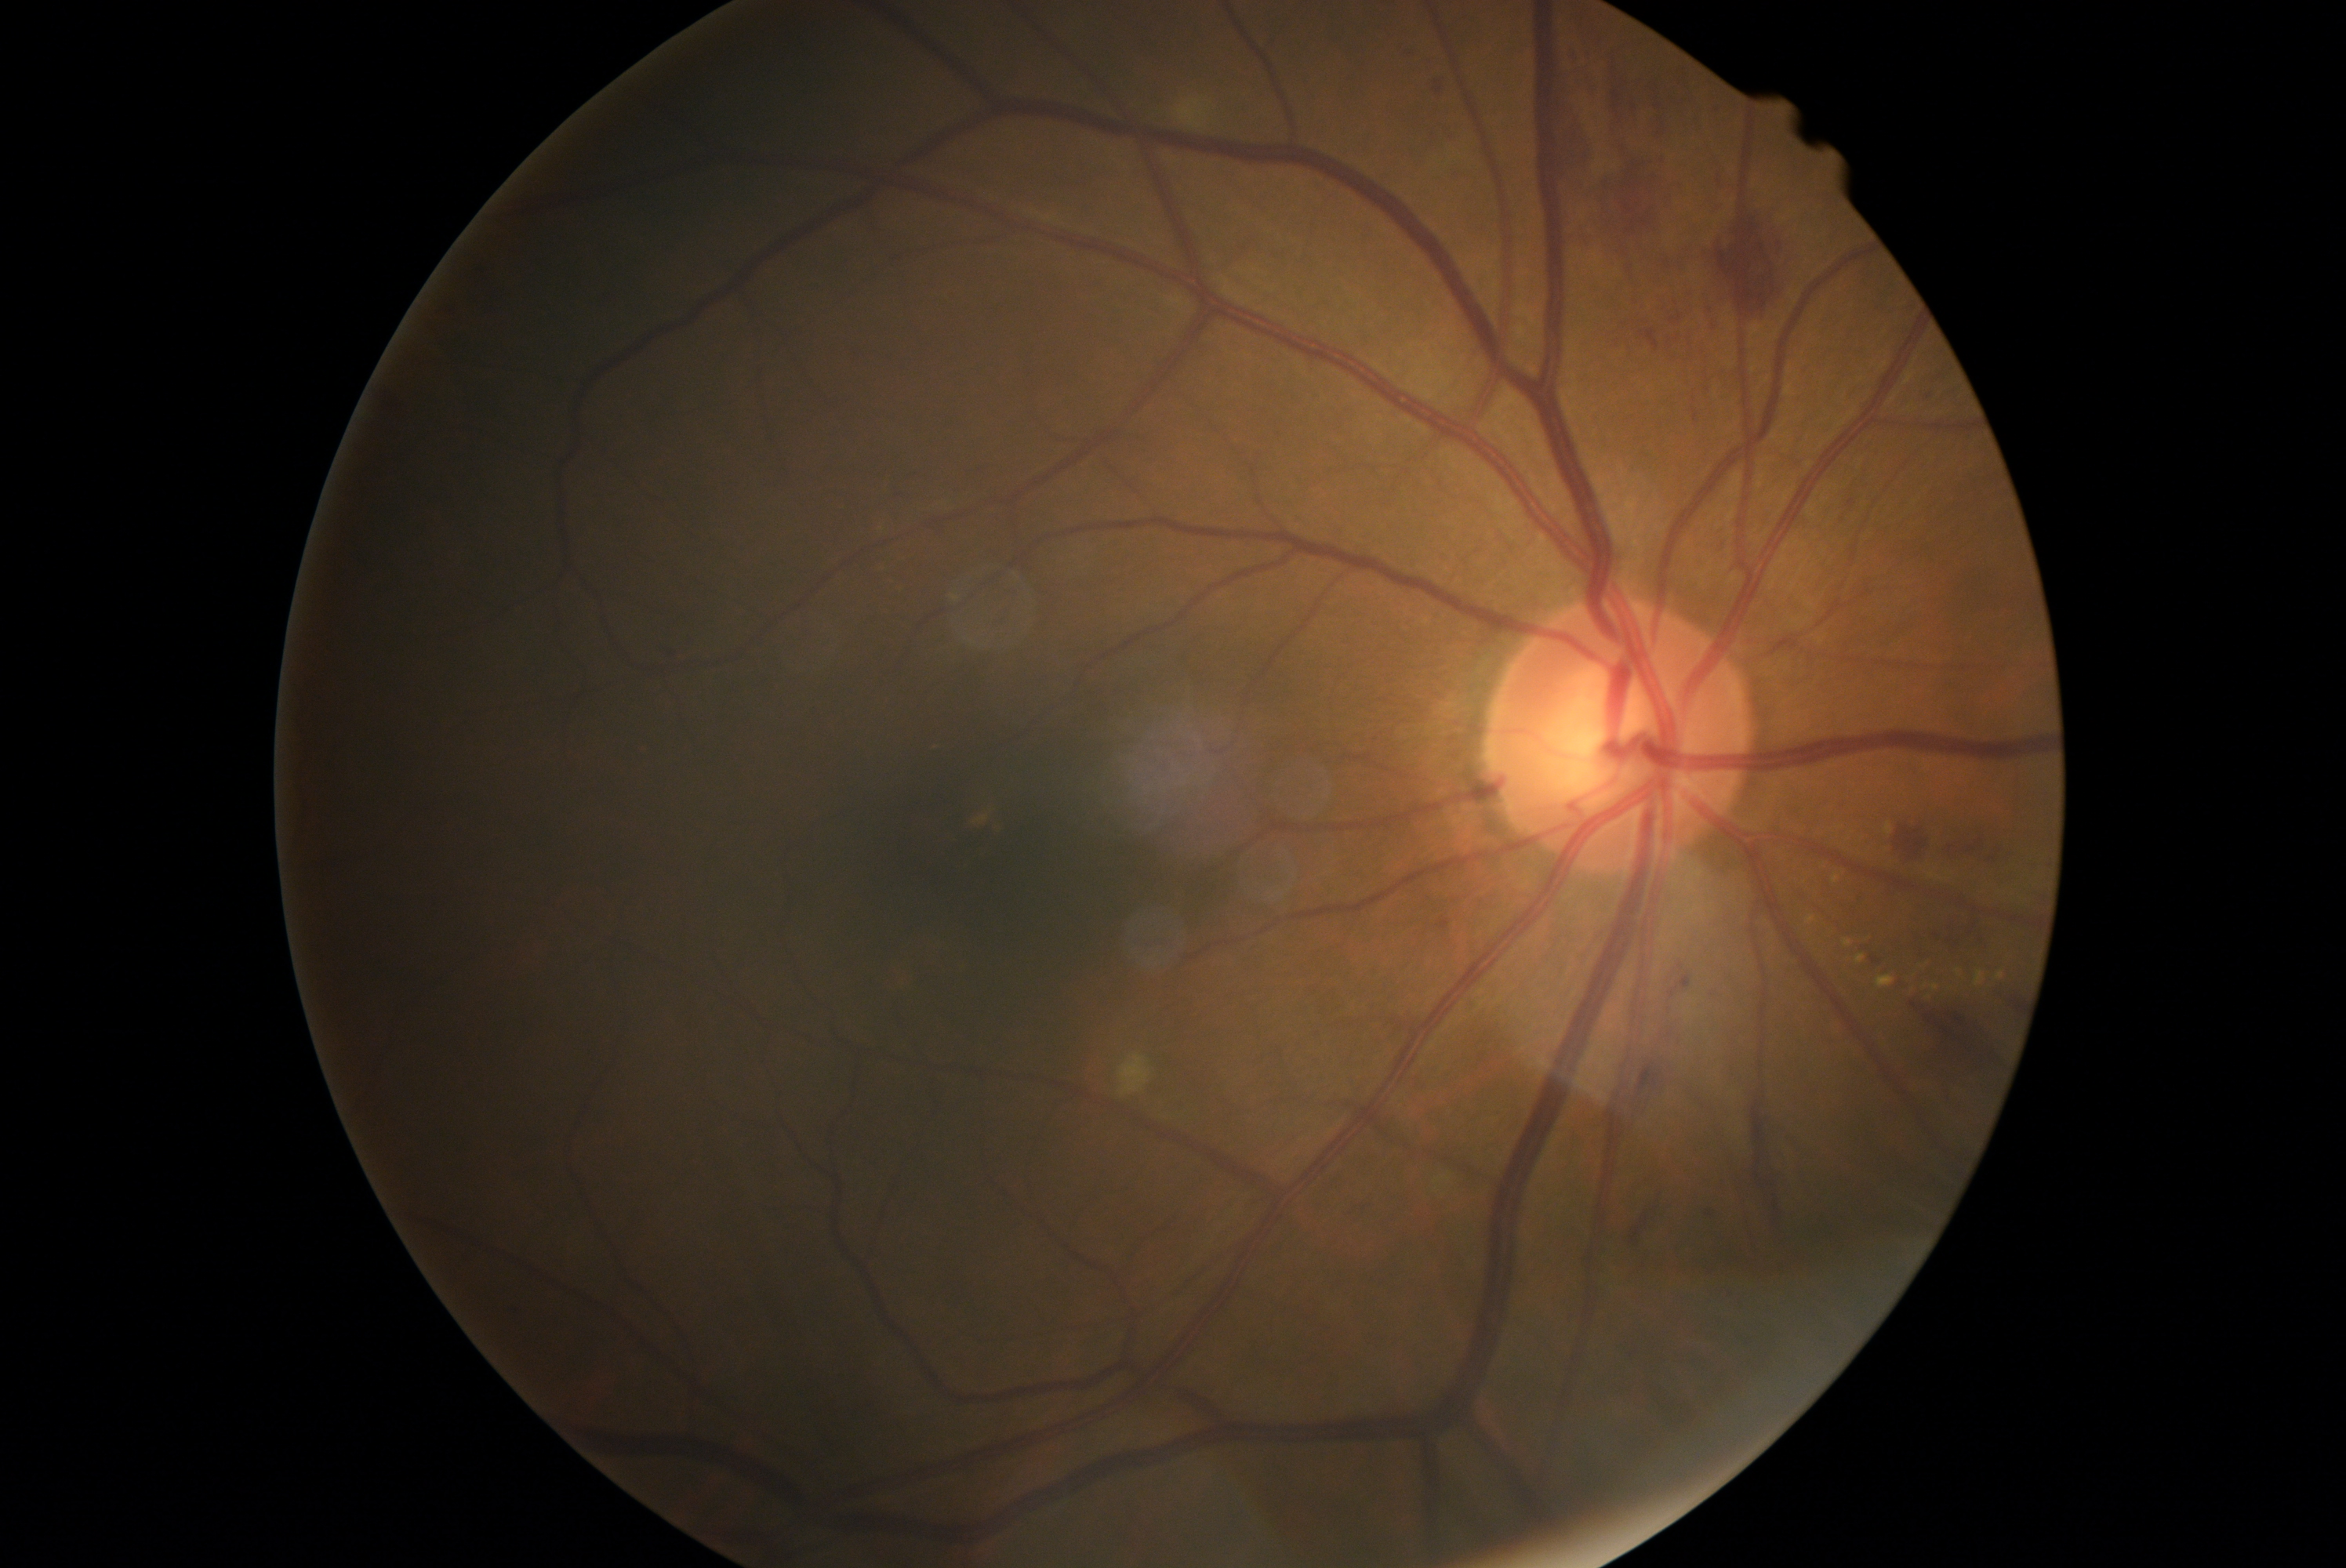

{
  "dr_grade": "grade 2 (moderate NPDR)"
}